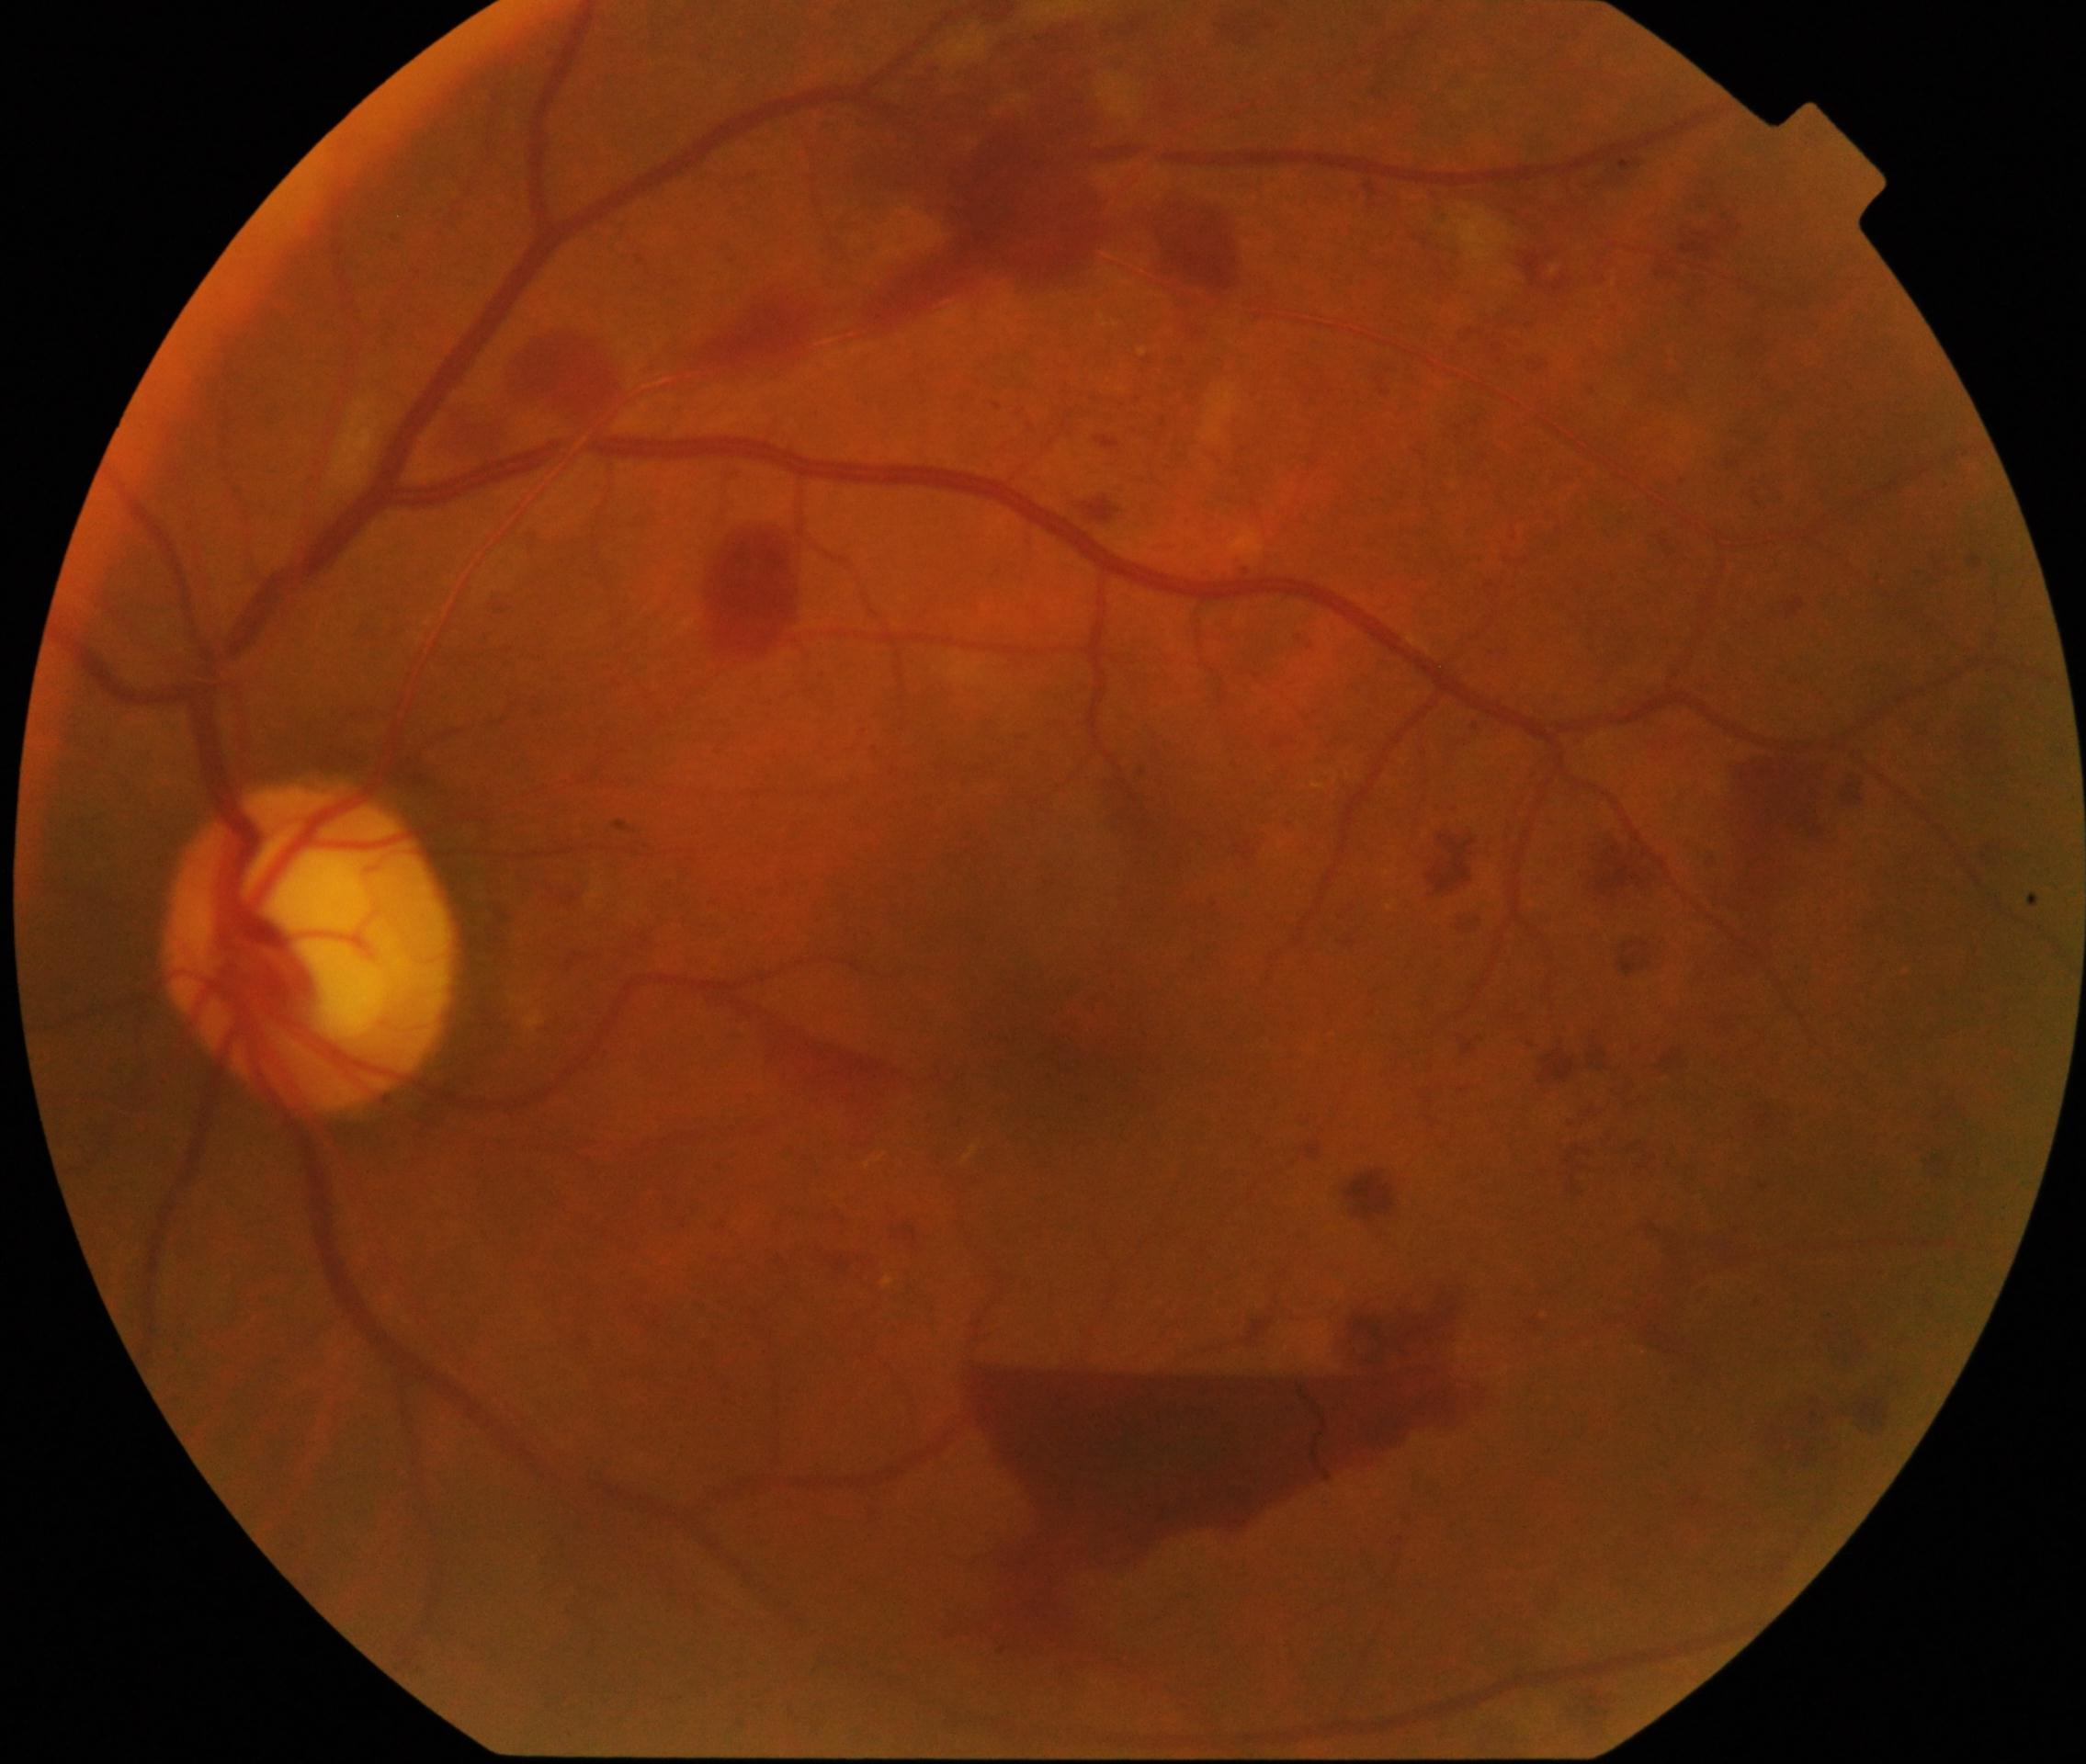

– DR class — proliferative diabetic retinopathy
– DR — grade 4 (PDR) — neovascularization and/or vitreous/pre-retinal hemorrhage